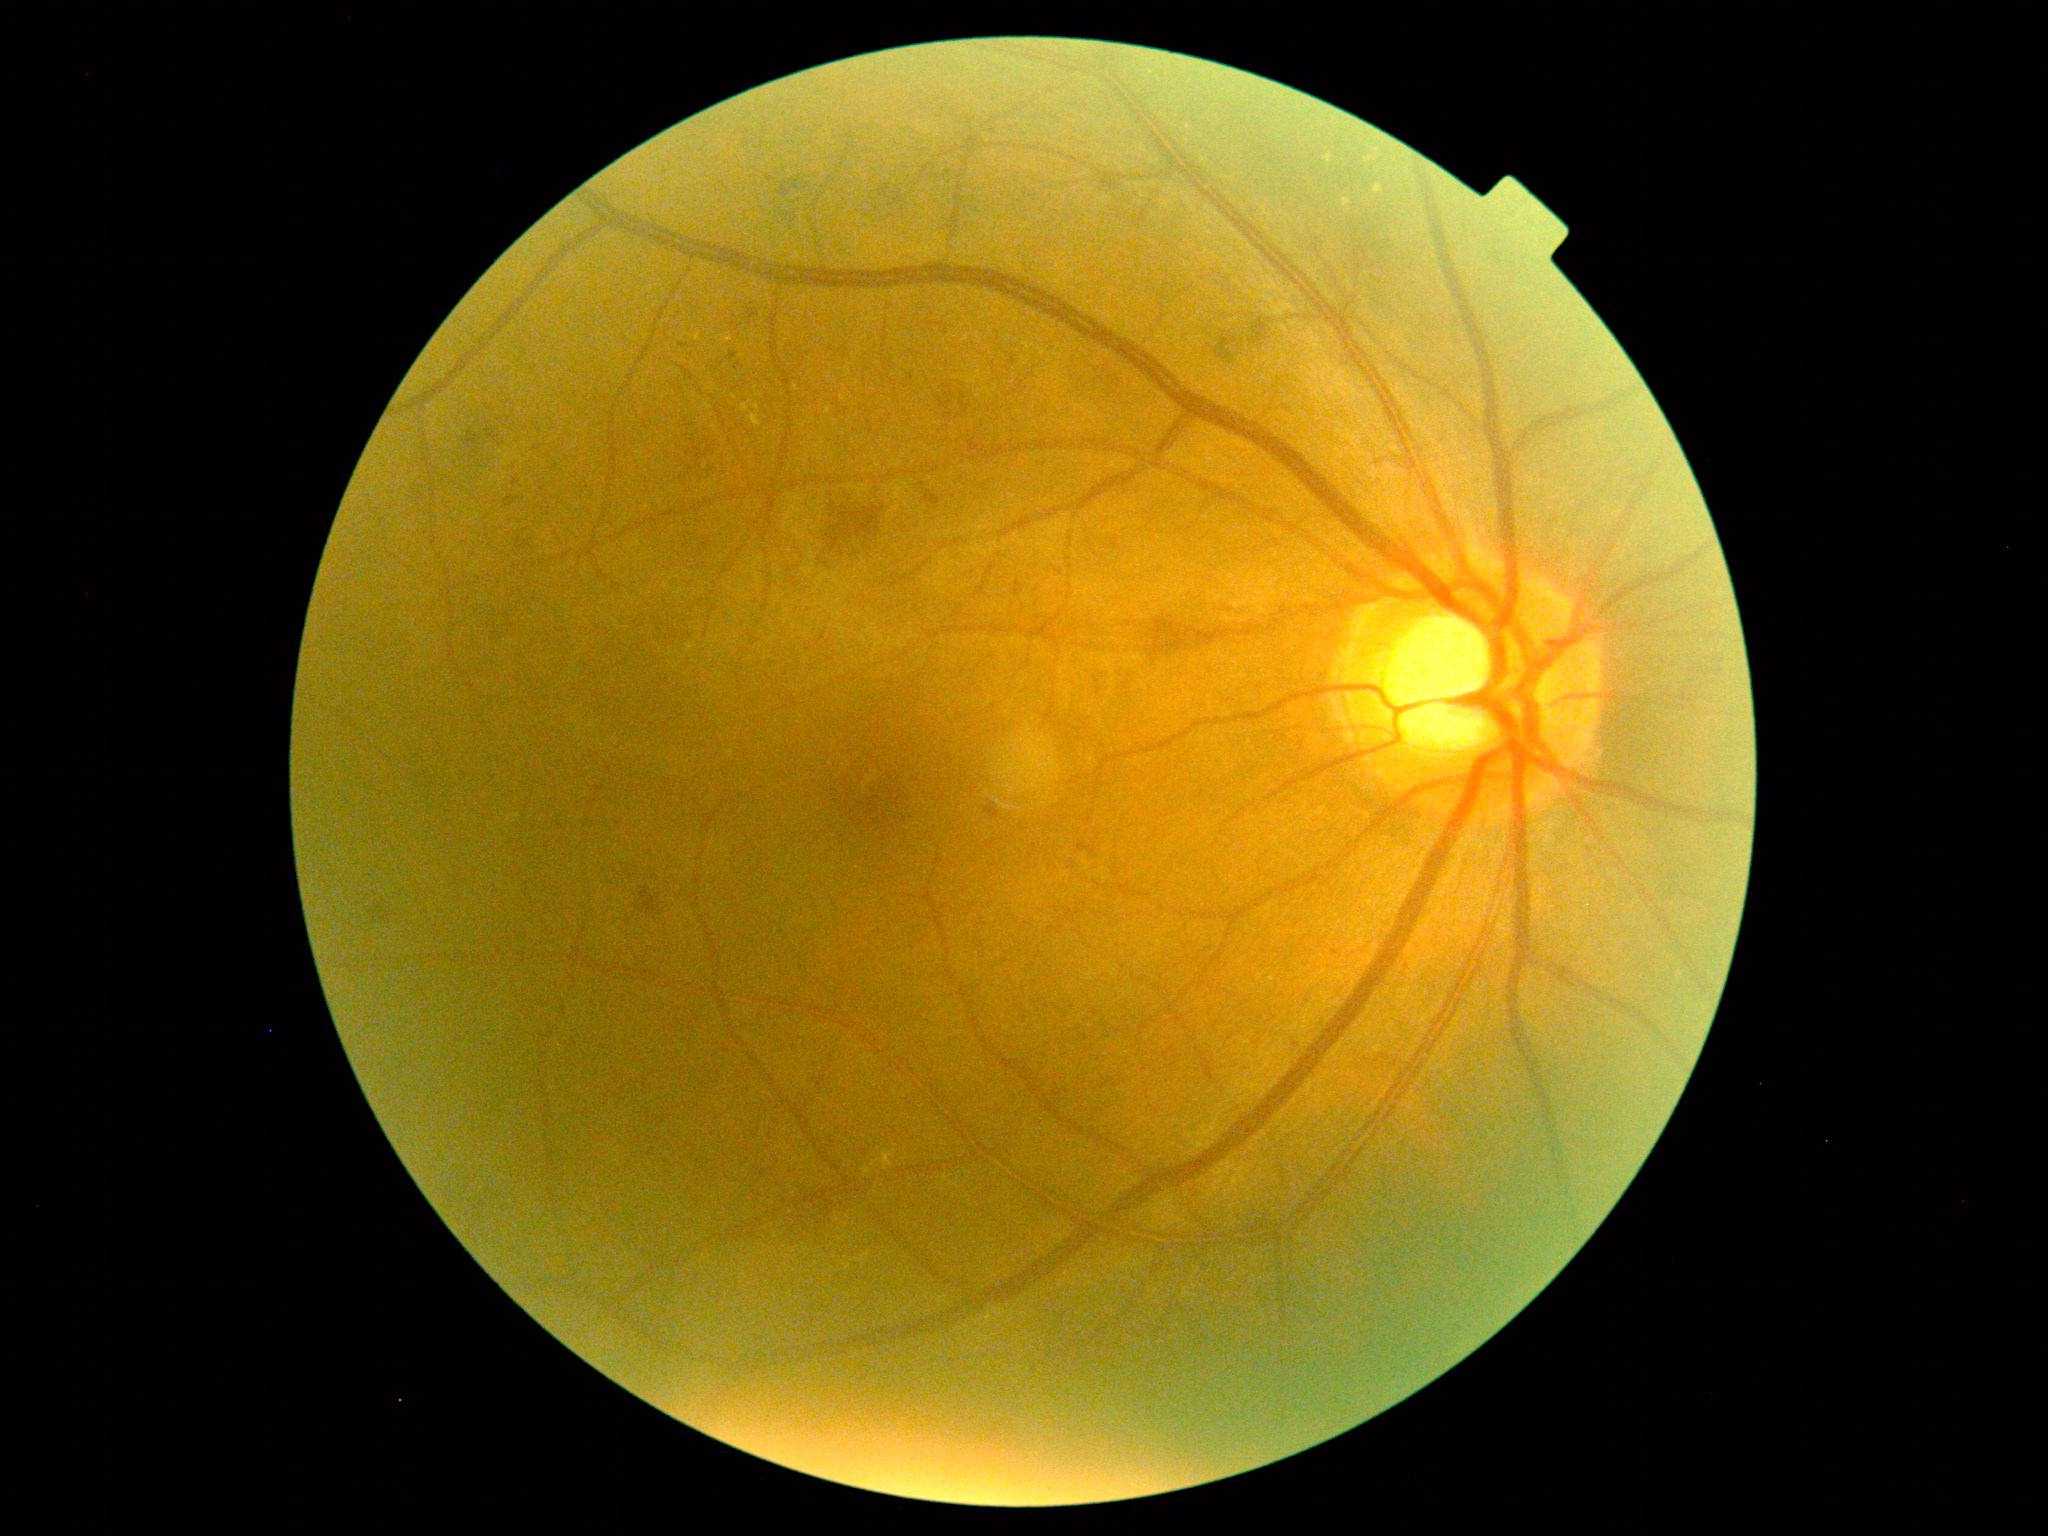

Diabetic retinopathy grade is 2.